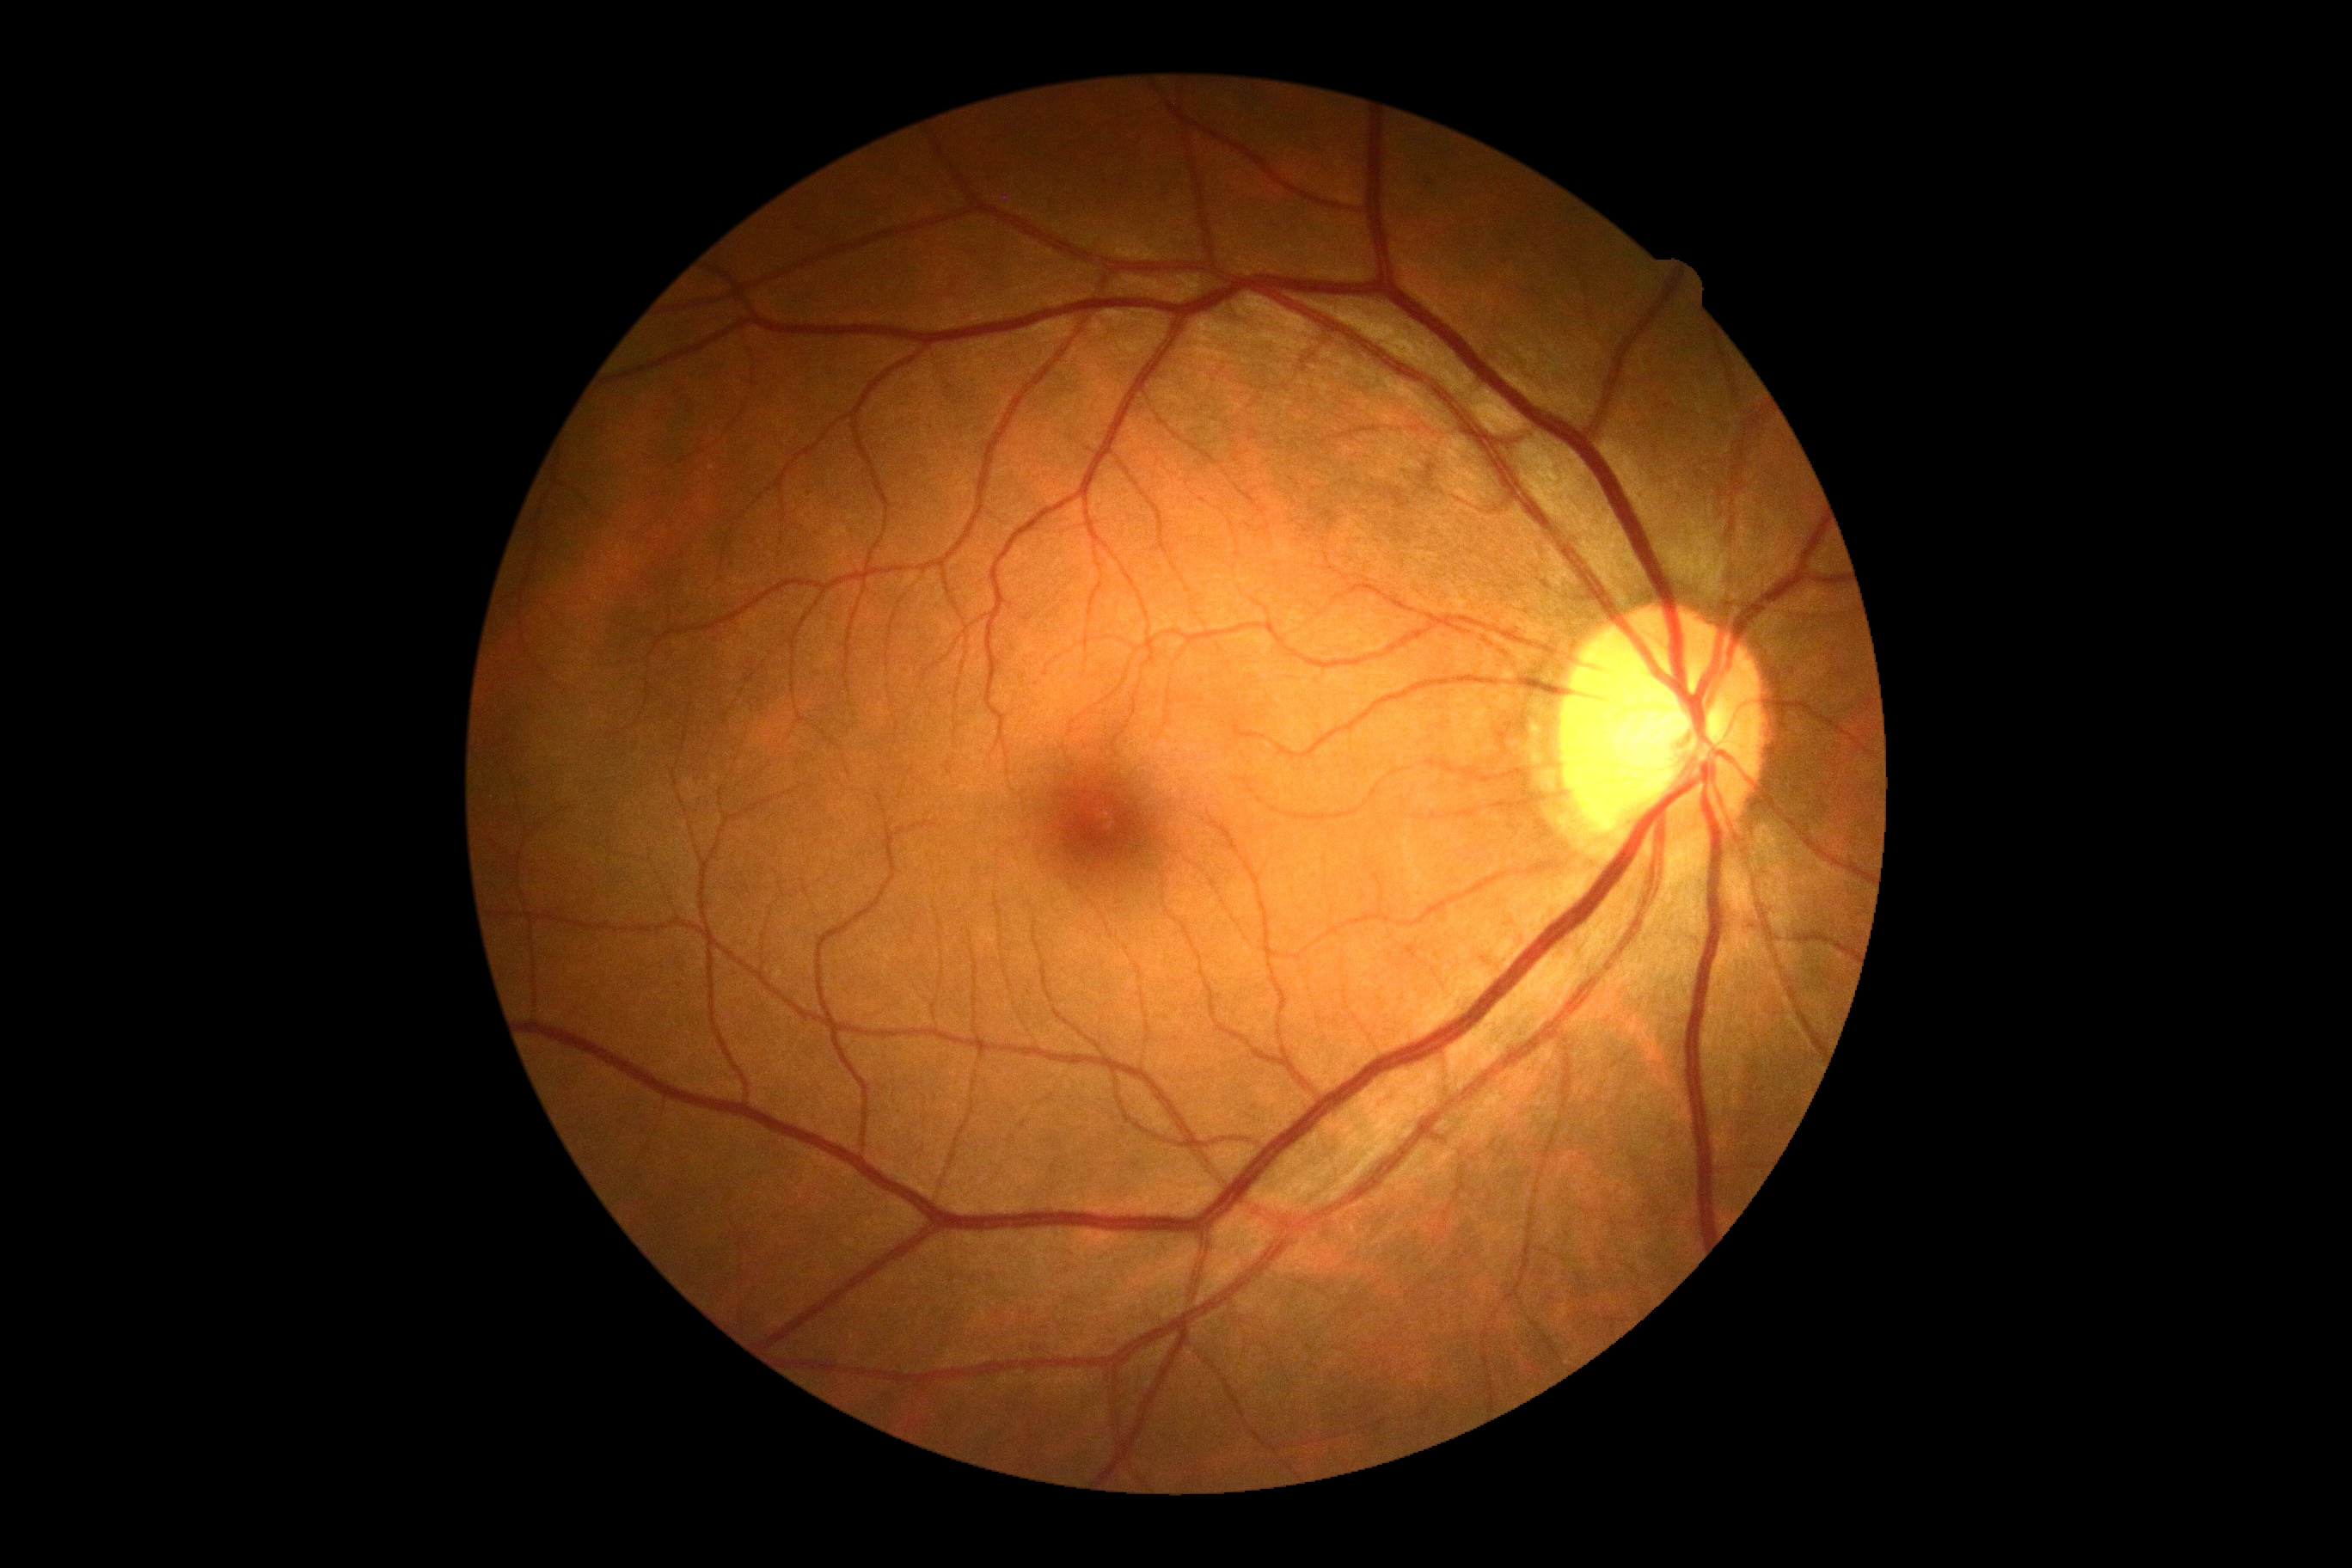 dr_impression: negative for DR
dr_grade: grade 0 (no apparent retinopathy)